50° field of view — 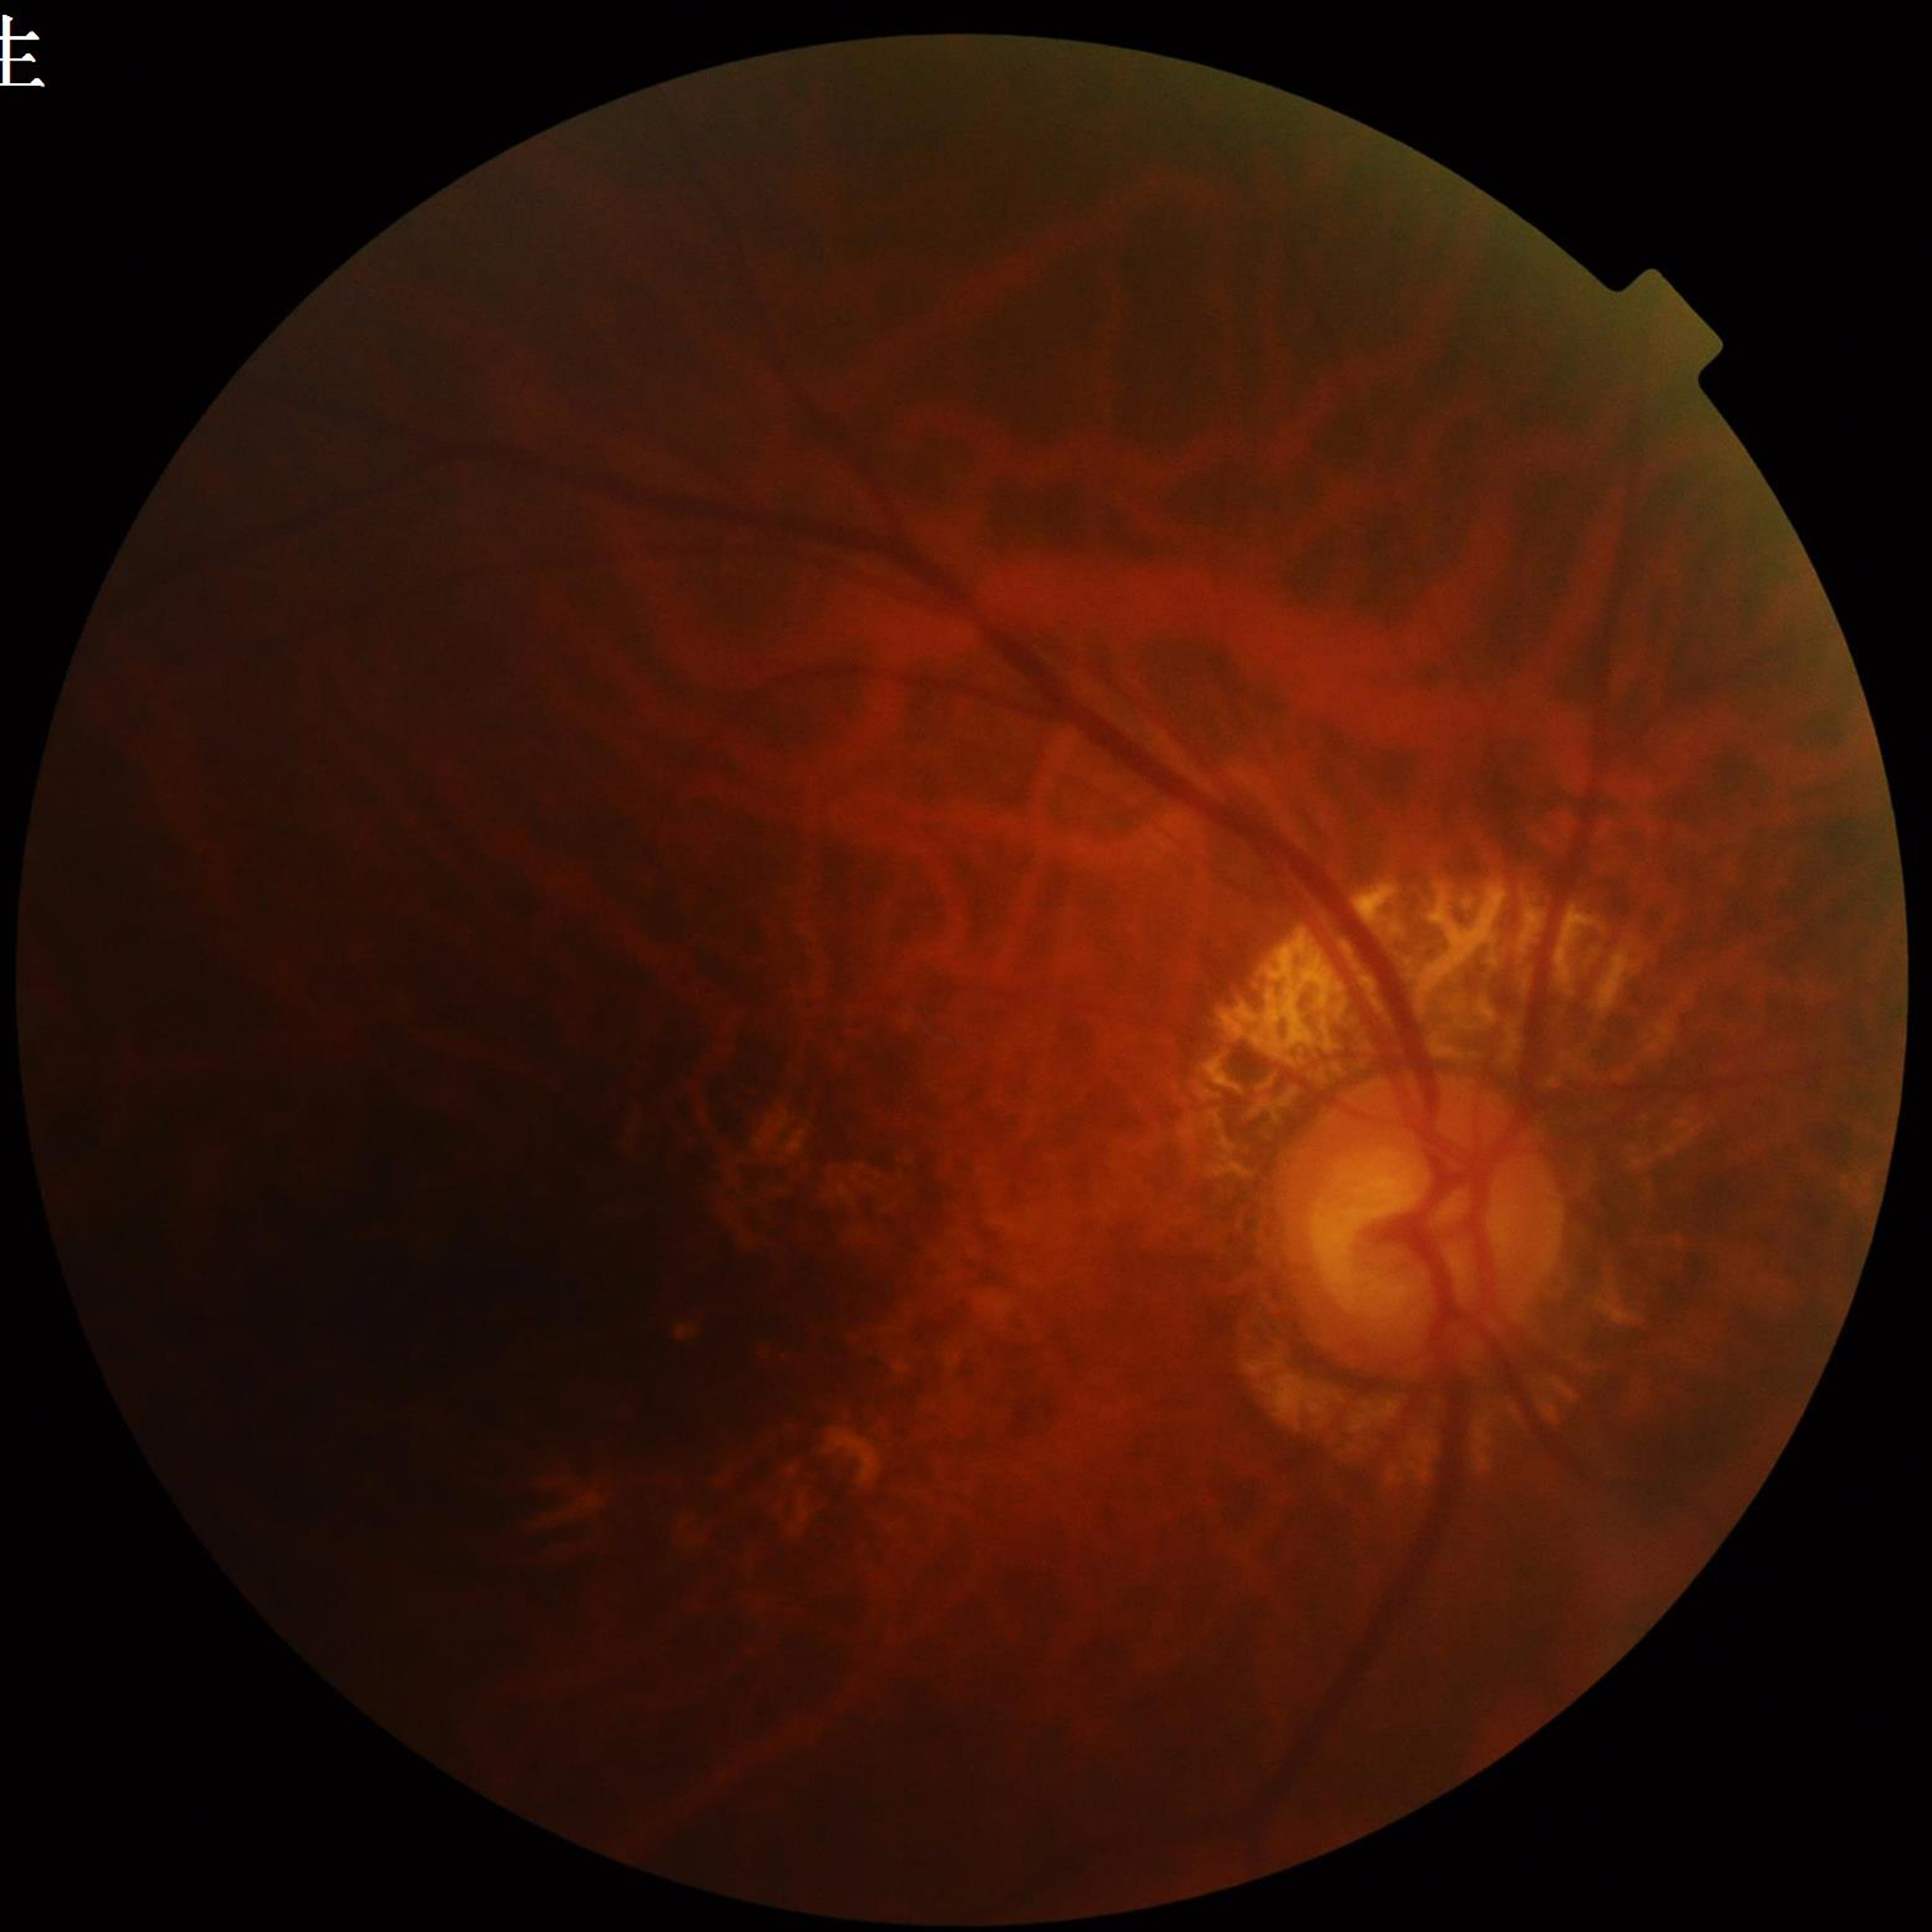

Image quality: issues noted — blur, illumination/color distortion
Diagnosis: DR